CFP
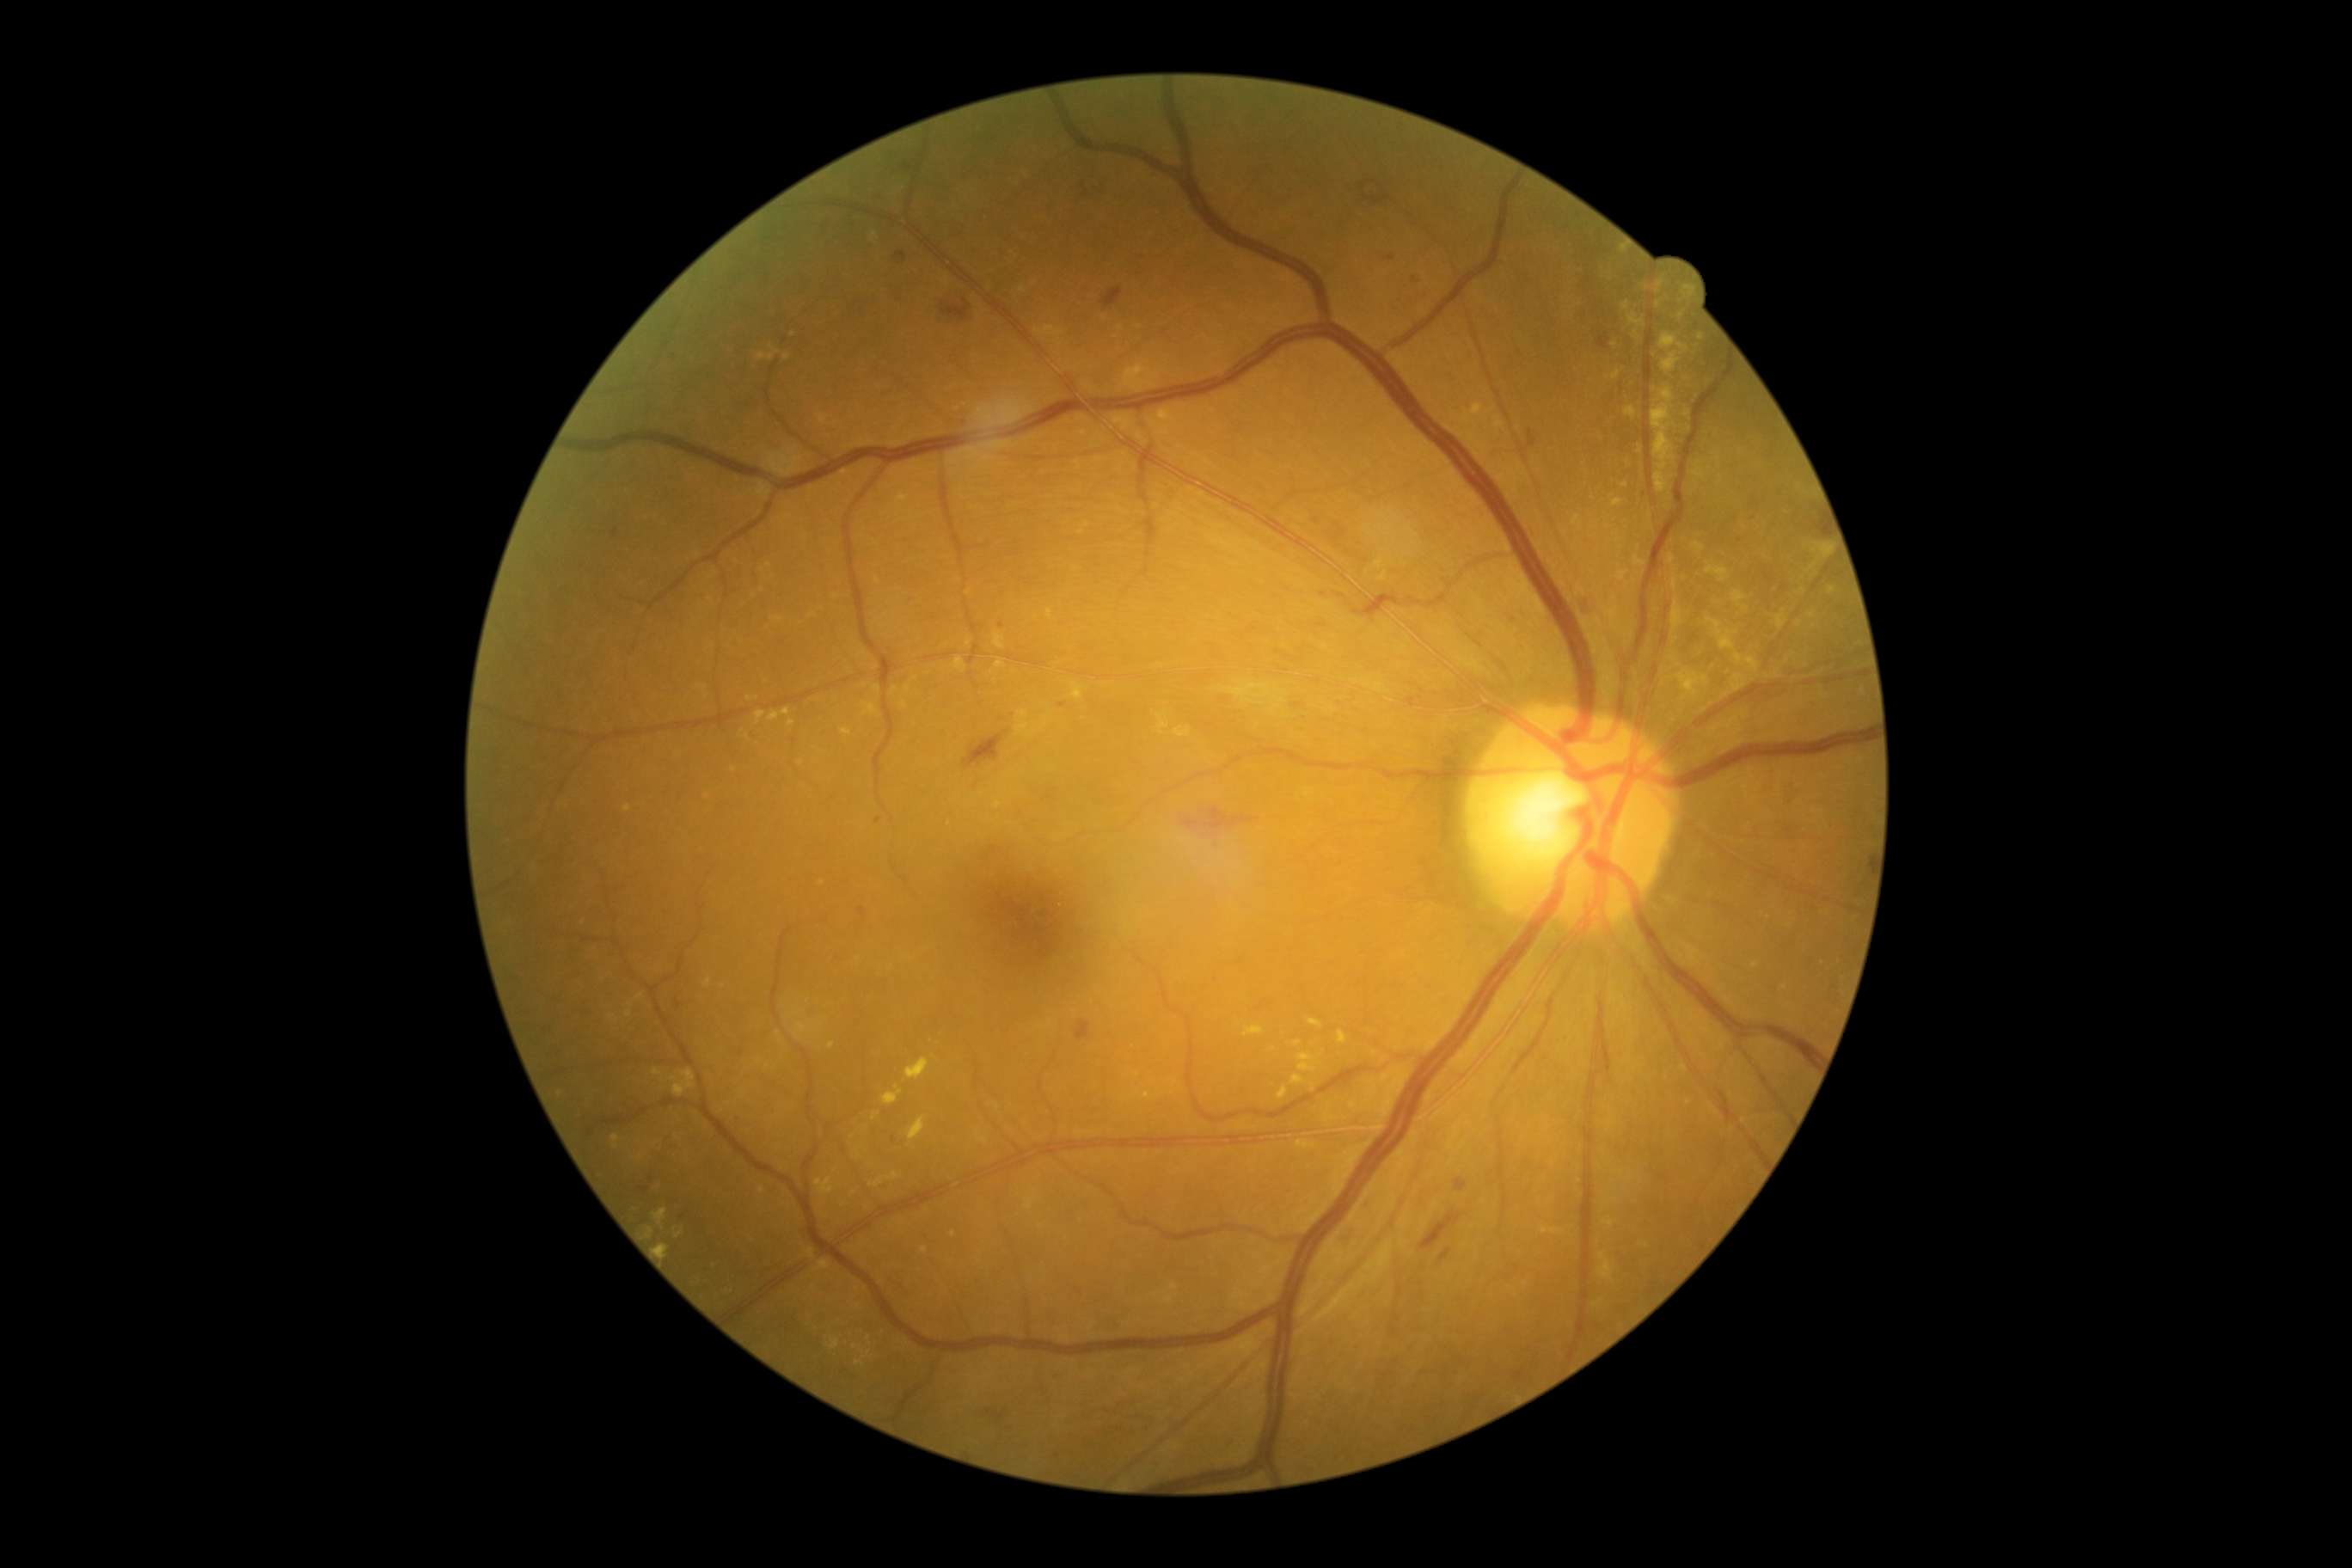

Diabetic retinopathy severity is moderate non-proliferative diabetic retinopathy (grade 2)
Selected lesions:
hard exudates (partial): {"left": 1734, "top": 654, "right": 1760, "bottom": 671} | {"left": 1624, "top": 407, "right": 1638, "bottom": 419} | {"left": 783, "top": 707, "right": 790, "bottom": 716} | {"left": 1777, "top": 609, "right": 1787, "bottom": 630} | {"left": 953, "top": 658, "right": 967, "bottom": 675} | {"left": 907, "top": 1058, "right": 929, "bottom": 1081} | {"left": 1705, "top": 618, "right": 1734, "bottom": 651} | {"left": 756, "top": 713, "right": 766, "bottom": 725} | {"left": 1828, "top": 587, "right": 1835, "bottom": 596} | {"left": 1612, "top": 499, "right": 1624, "bottom": 508} | {"left": 1672, "top": 570, "right": 1677, "bottom": 592}
Hard exudates (small, approximate centers) near (x=749, y=699) | (x=1640, y=451) | (x=1579, y=305) | (x=1658, y=305) | (x=1799, y=486) | (x=679, y=1235) | (x=1679, y=665)